Retinal fundus photograph
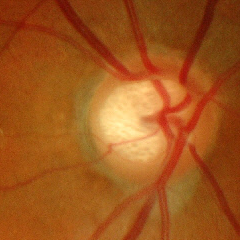
Demonstrates advanced-stage glaucoma.